Captured after pupil dilation:
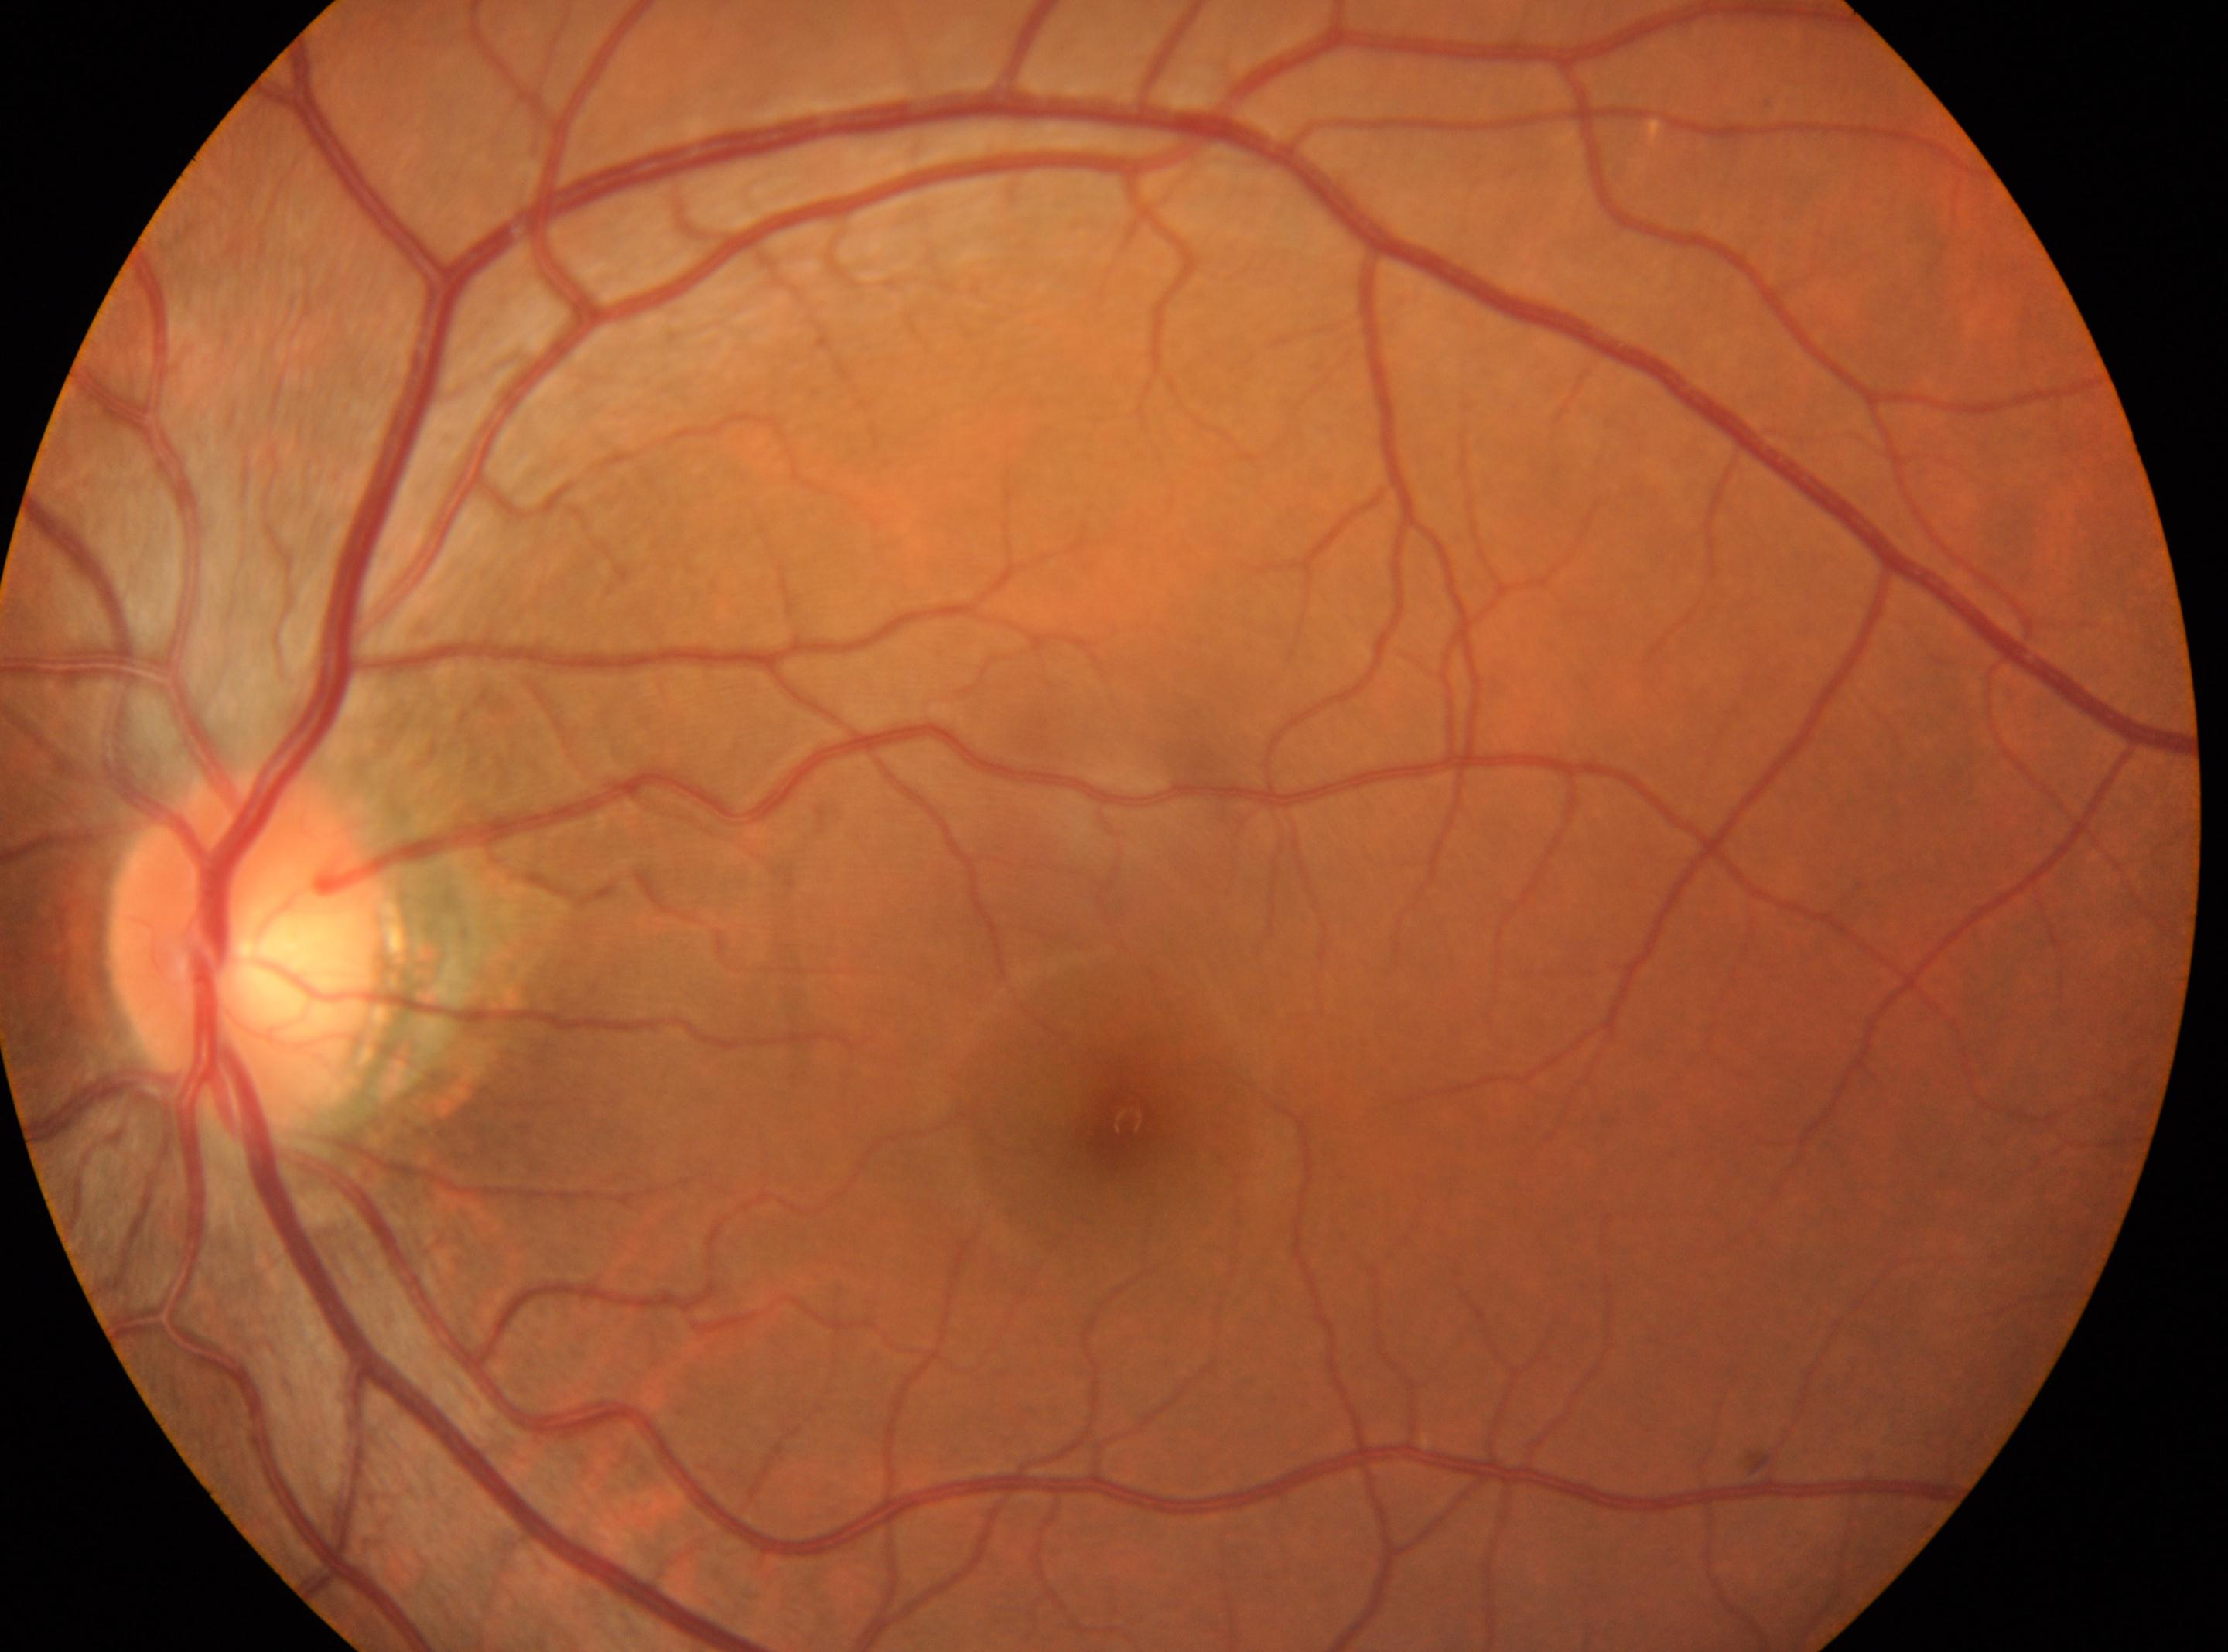
ONH=[248, 947]; left eye; diabetic retinopathy=grade 0 (no apparent retinopathy); fovea centralis=[1126, 1120]; No diabetic retinal disease findings.